Modified Davis grading — 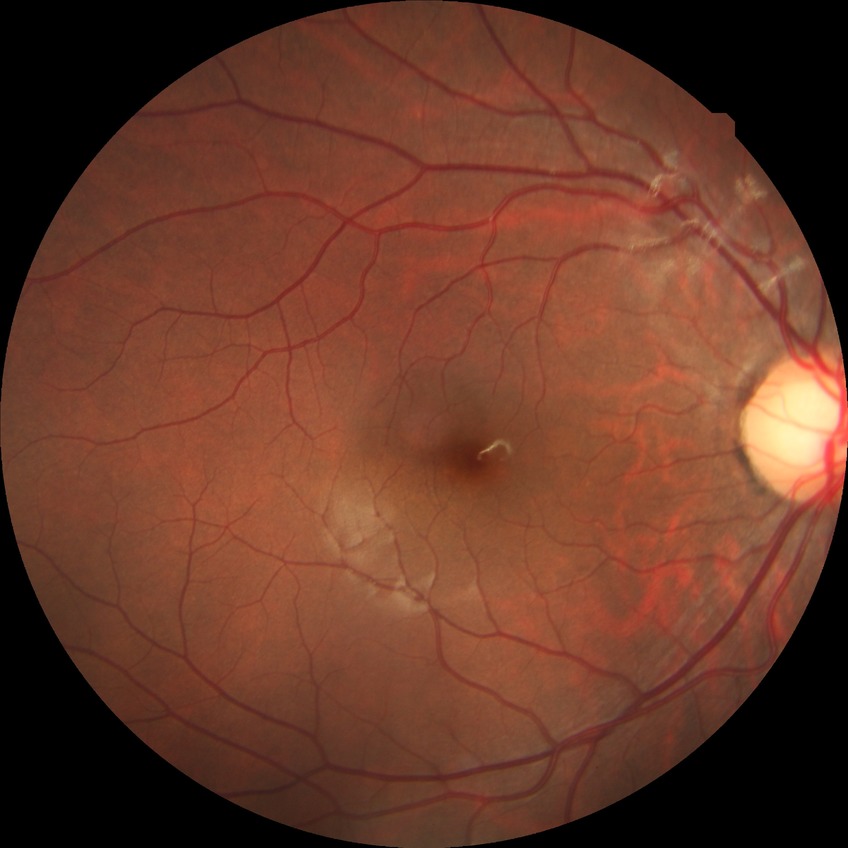

retinopathy stage: no diabetic retinopathy.